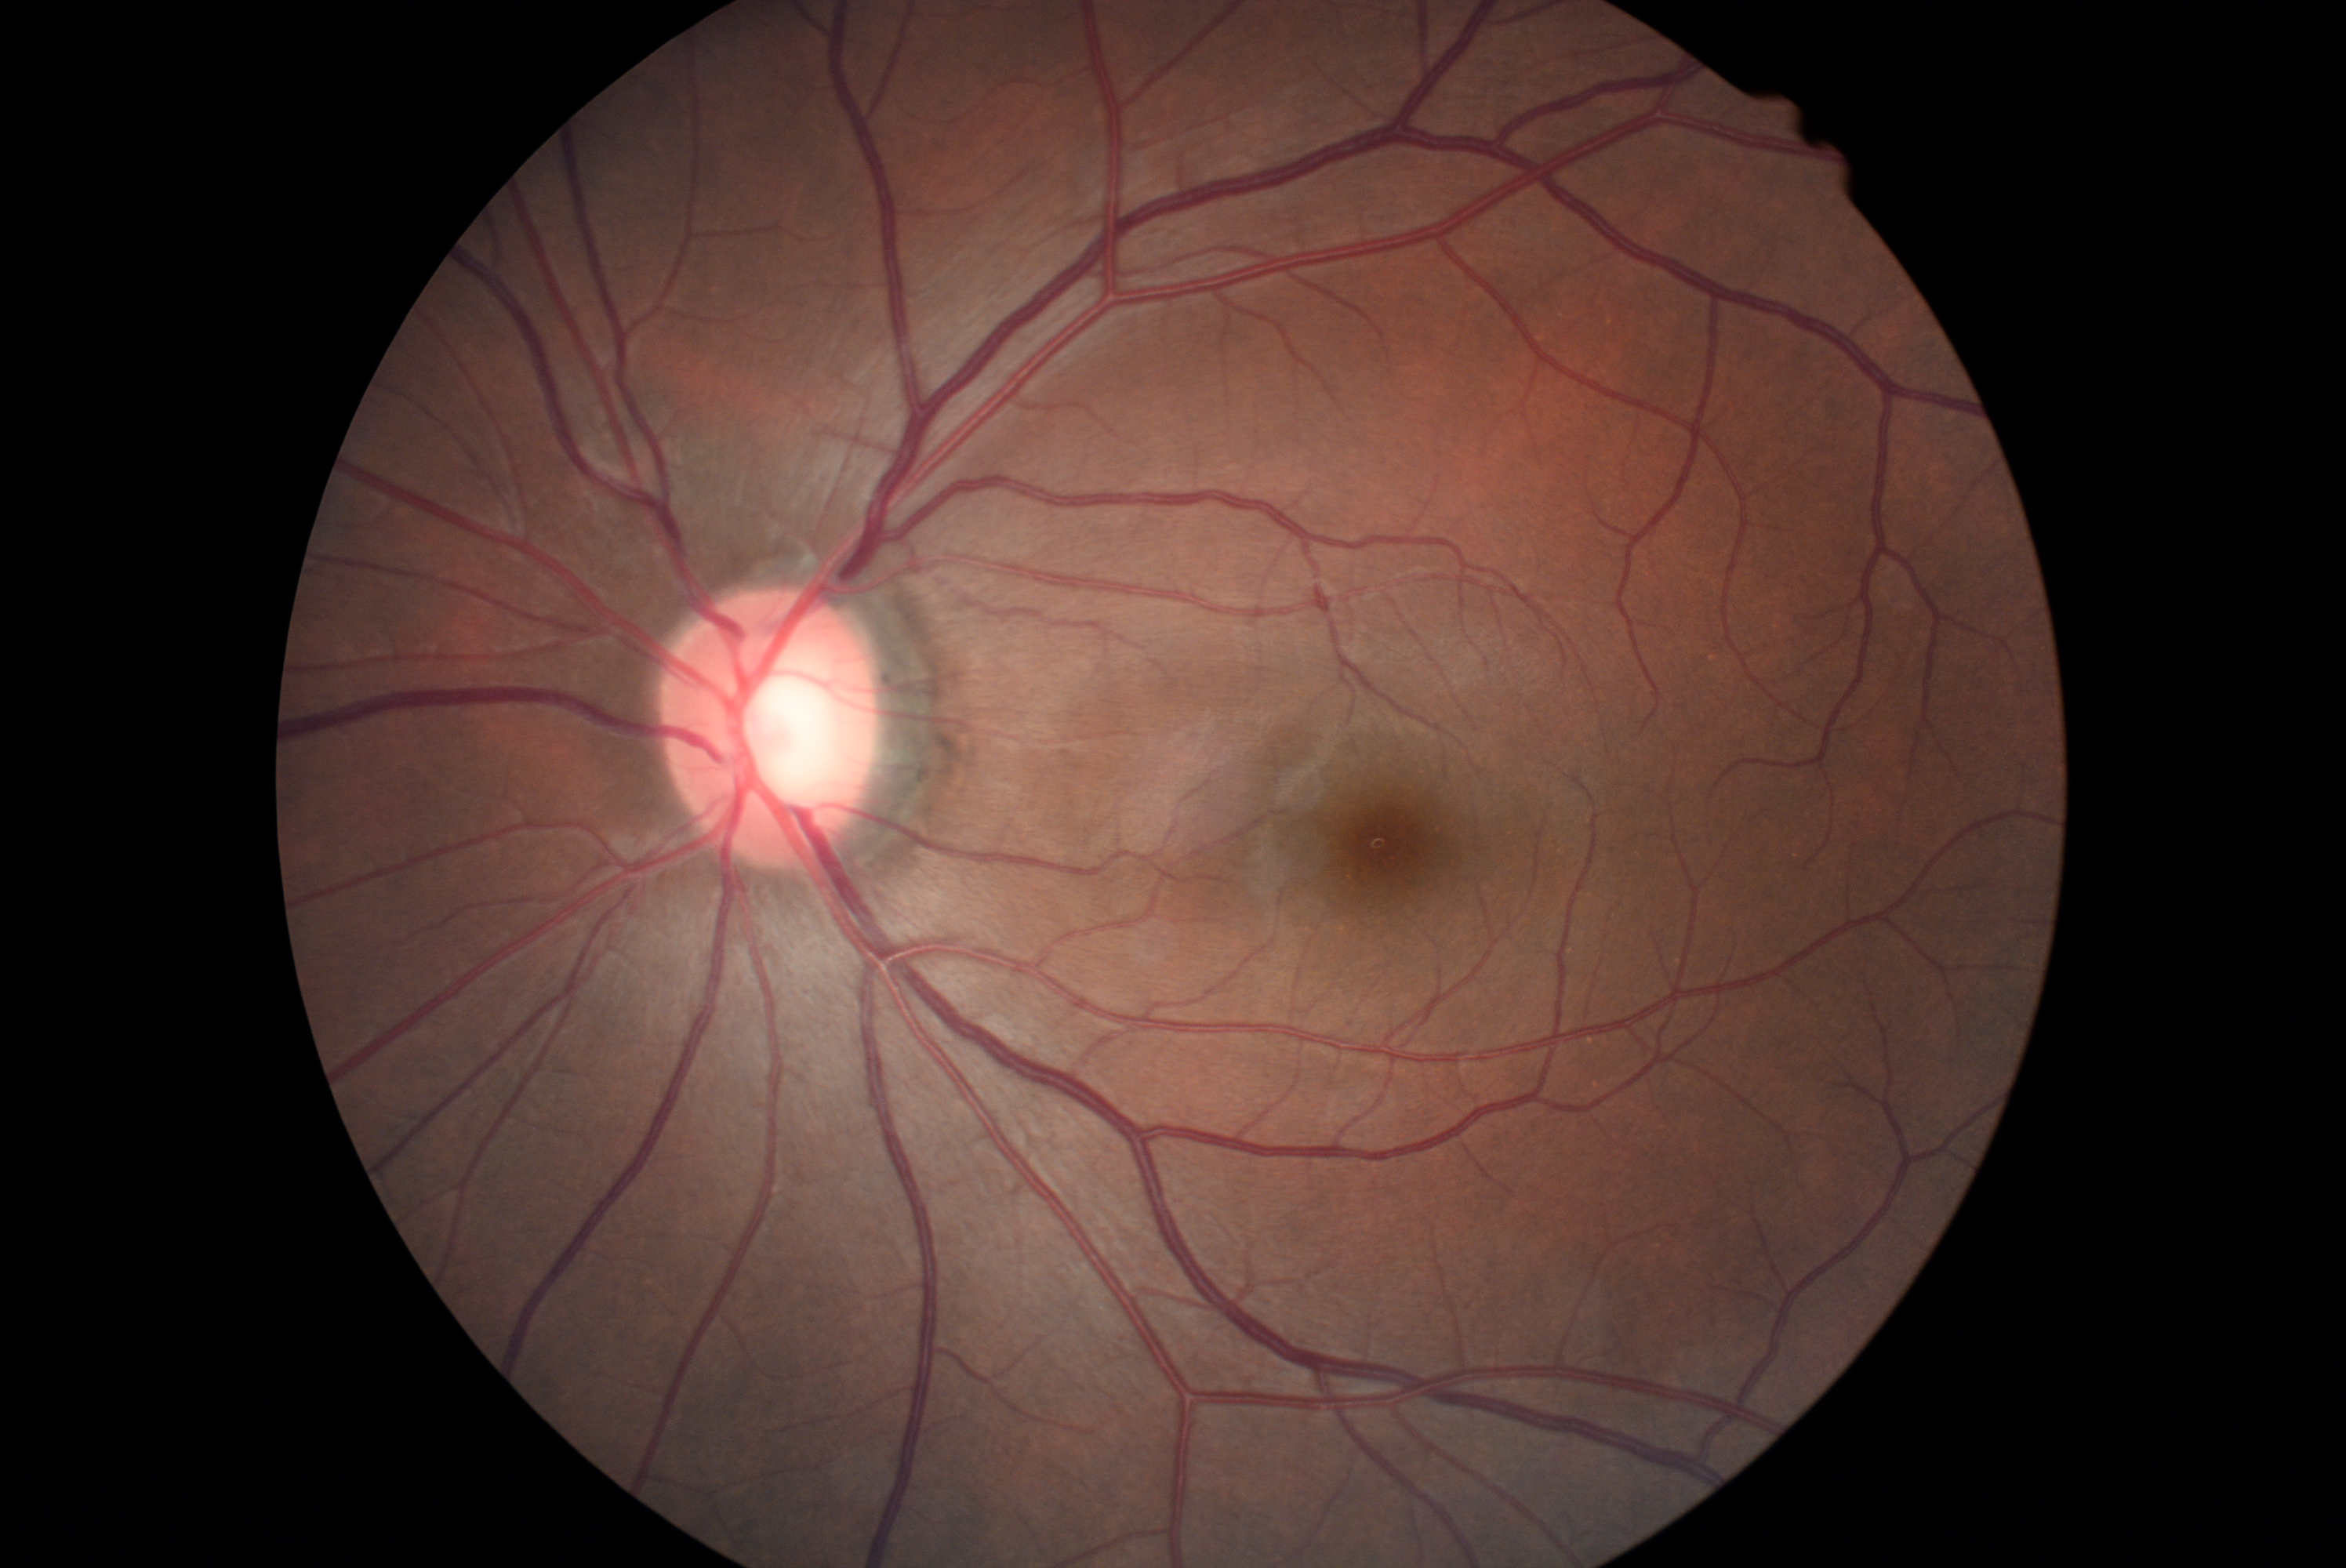
Diabetic retinopathy: grade 0.
No signs of diabetic retinopathy.